FOV: 200 degrees. 1924x1556. Ultra-widefield (UWF) fundus image — 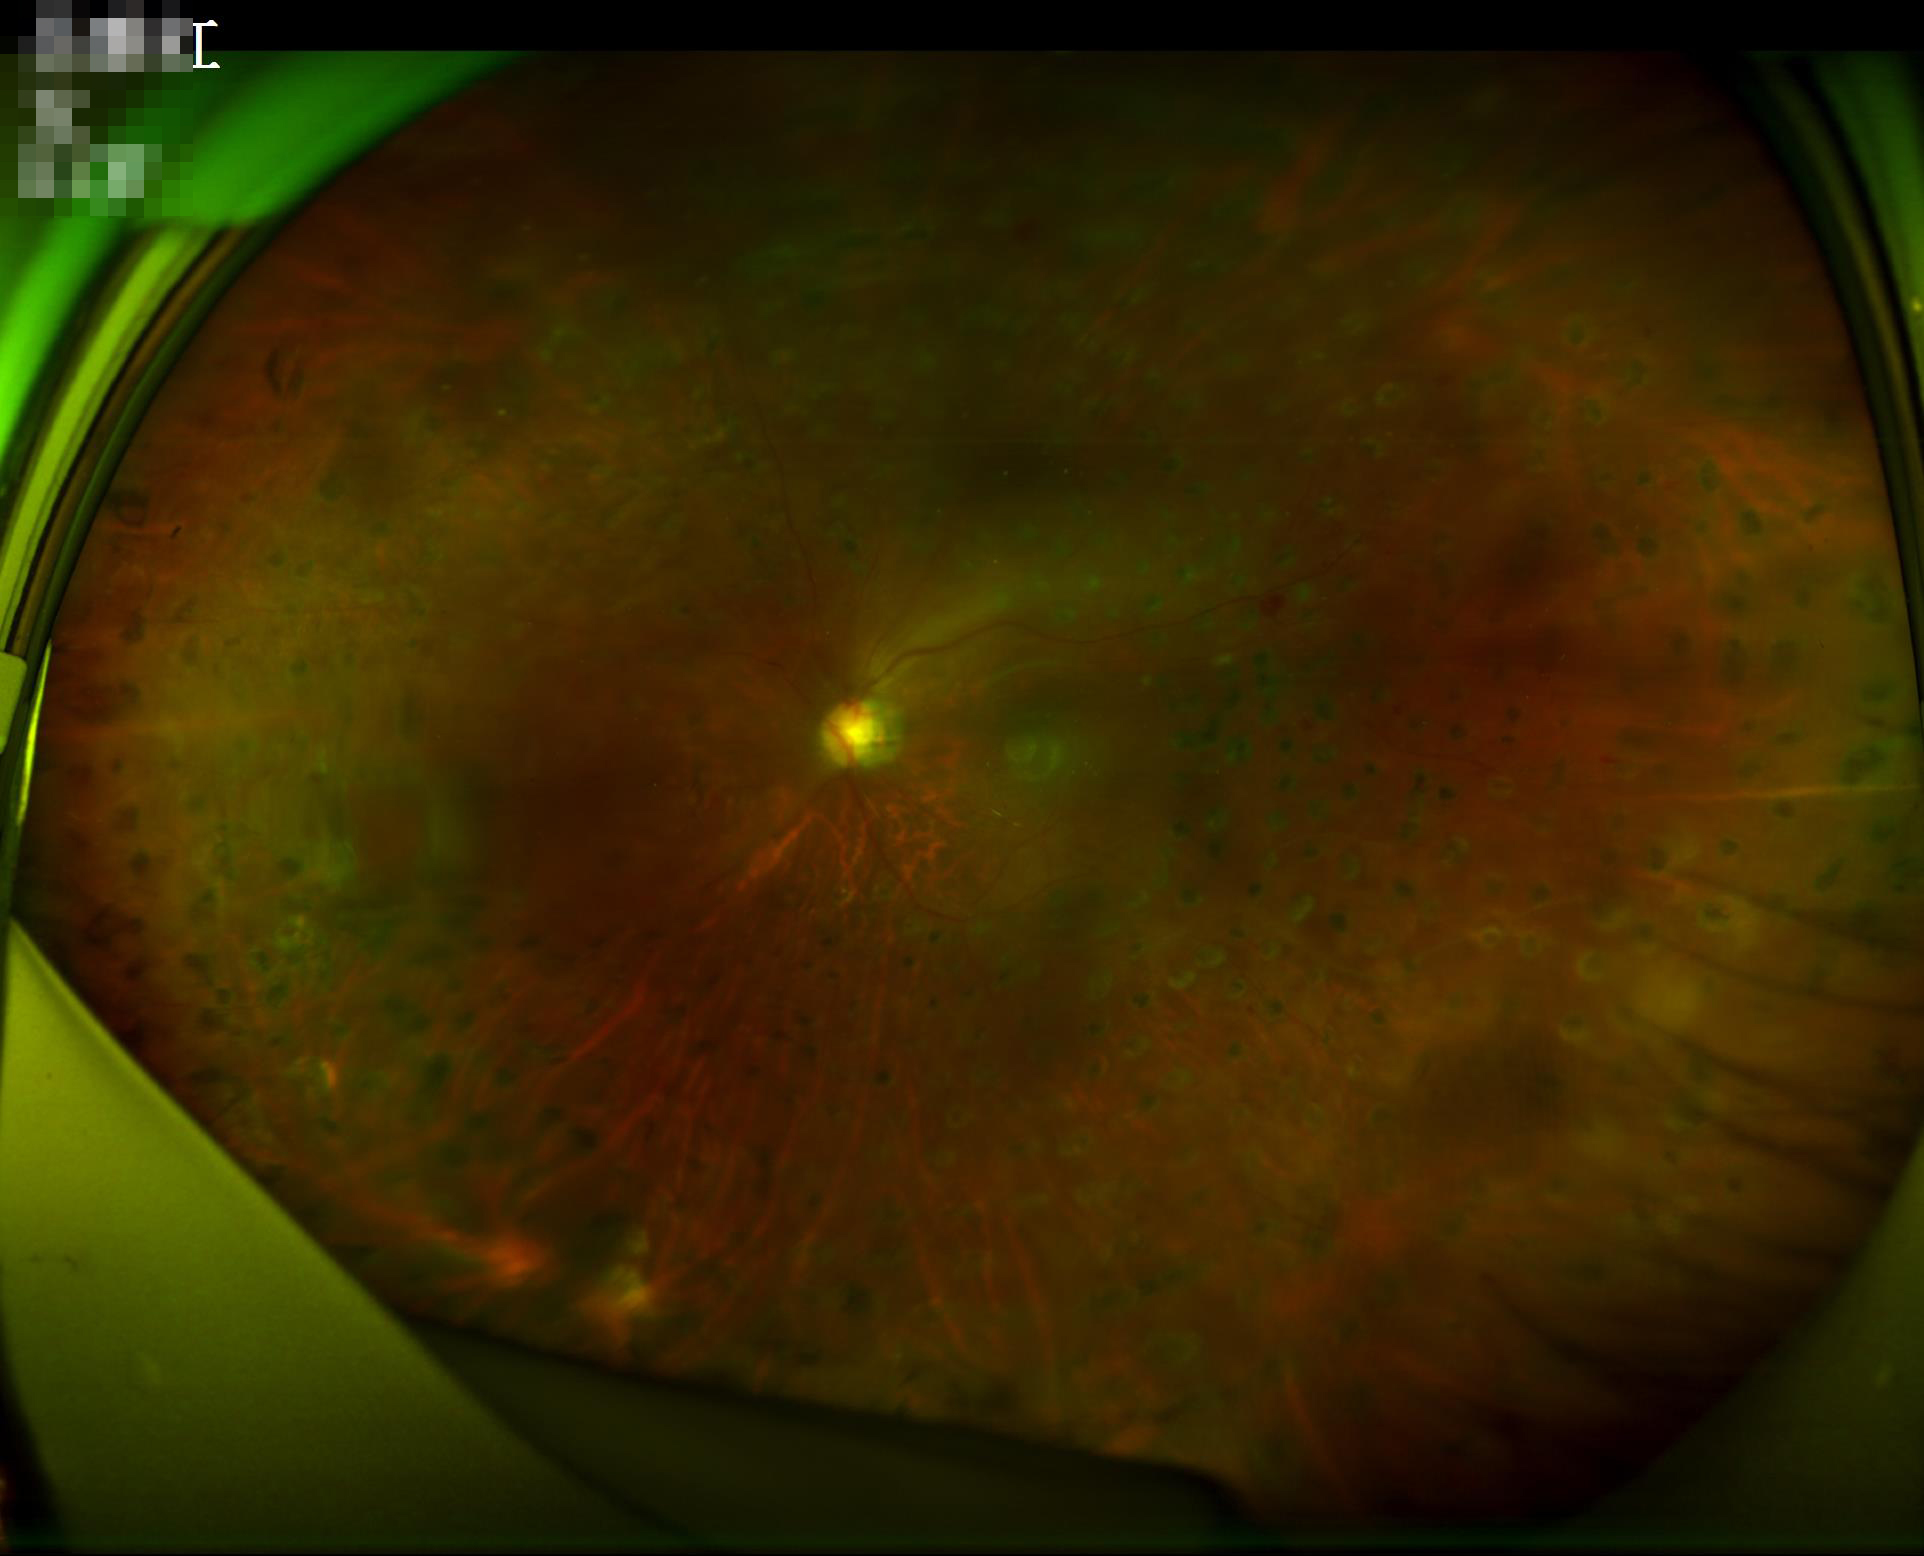
Overall quality is poor; the image is difficult to grade. Illumination is even. Narrow intensity range; structures are hard to distinguish. Reduced sharpness with visible blur.